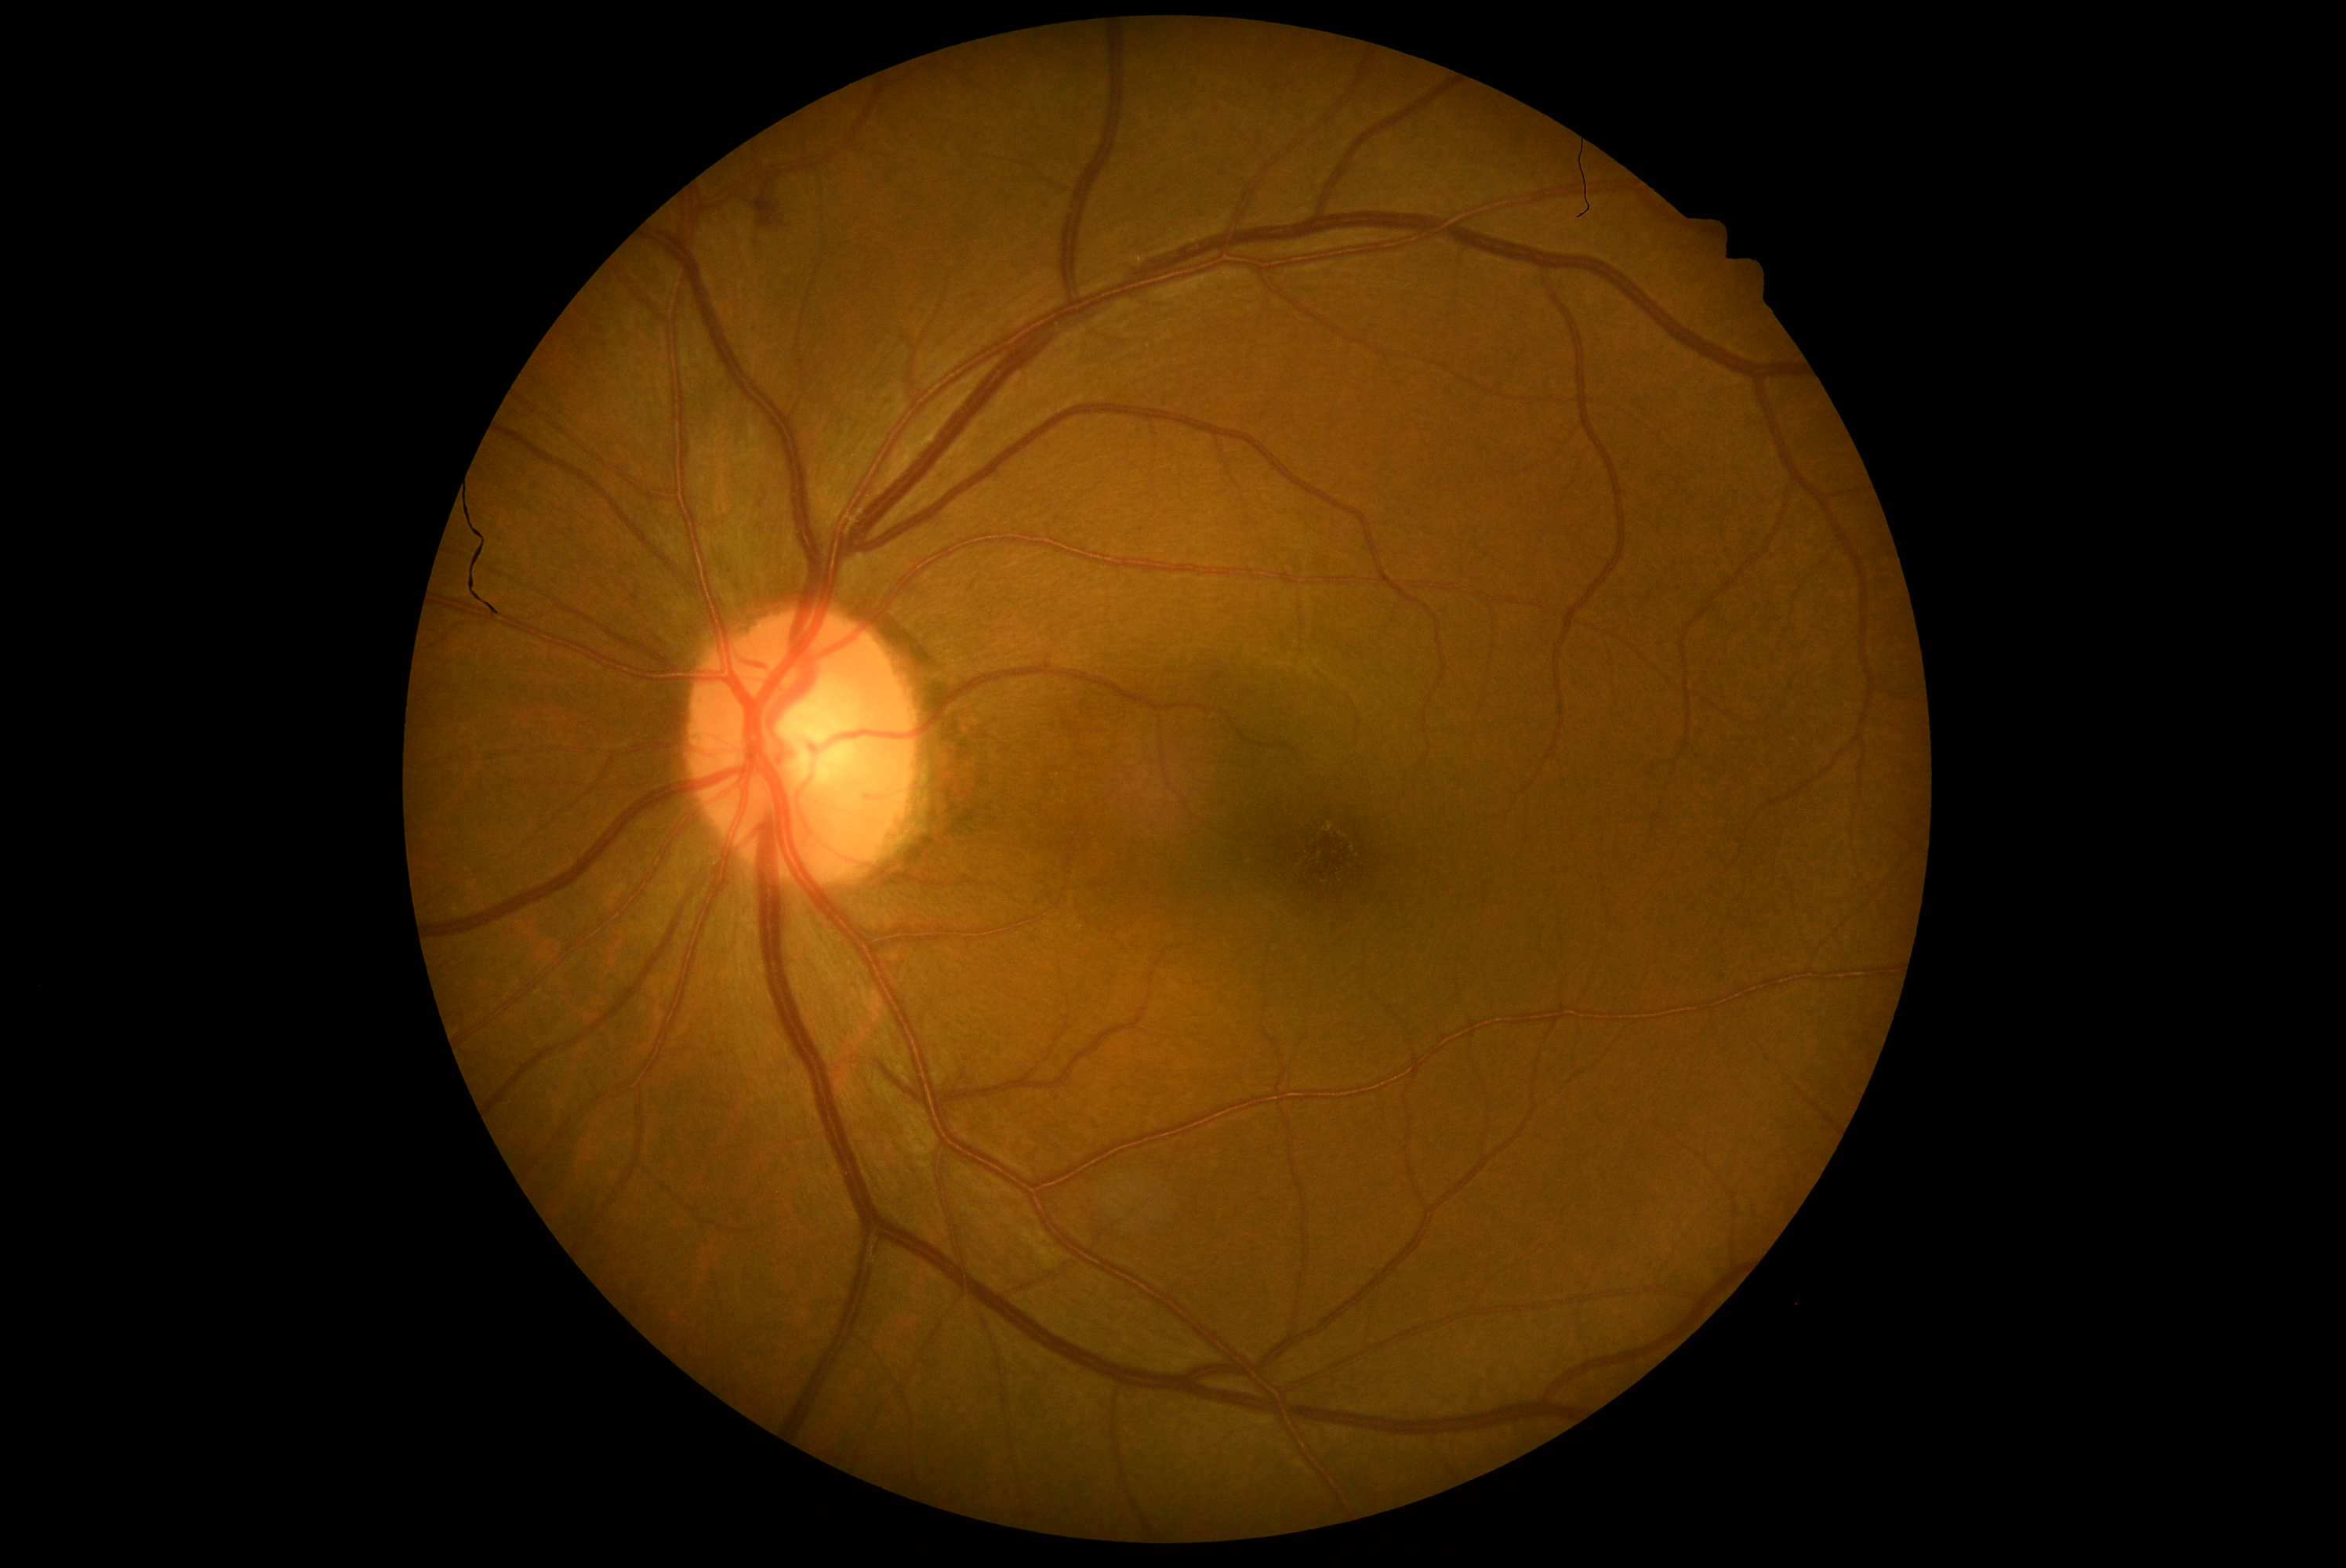

{"dr_grade": "moderate NPDR (grade 2)"}